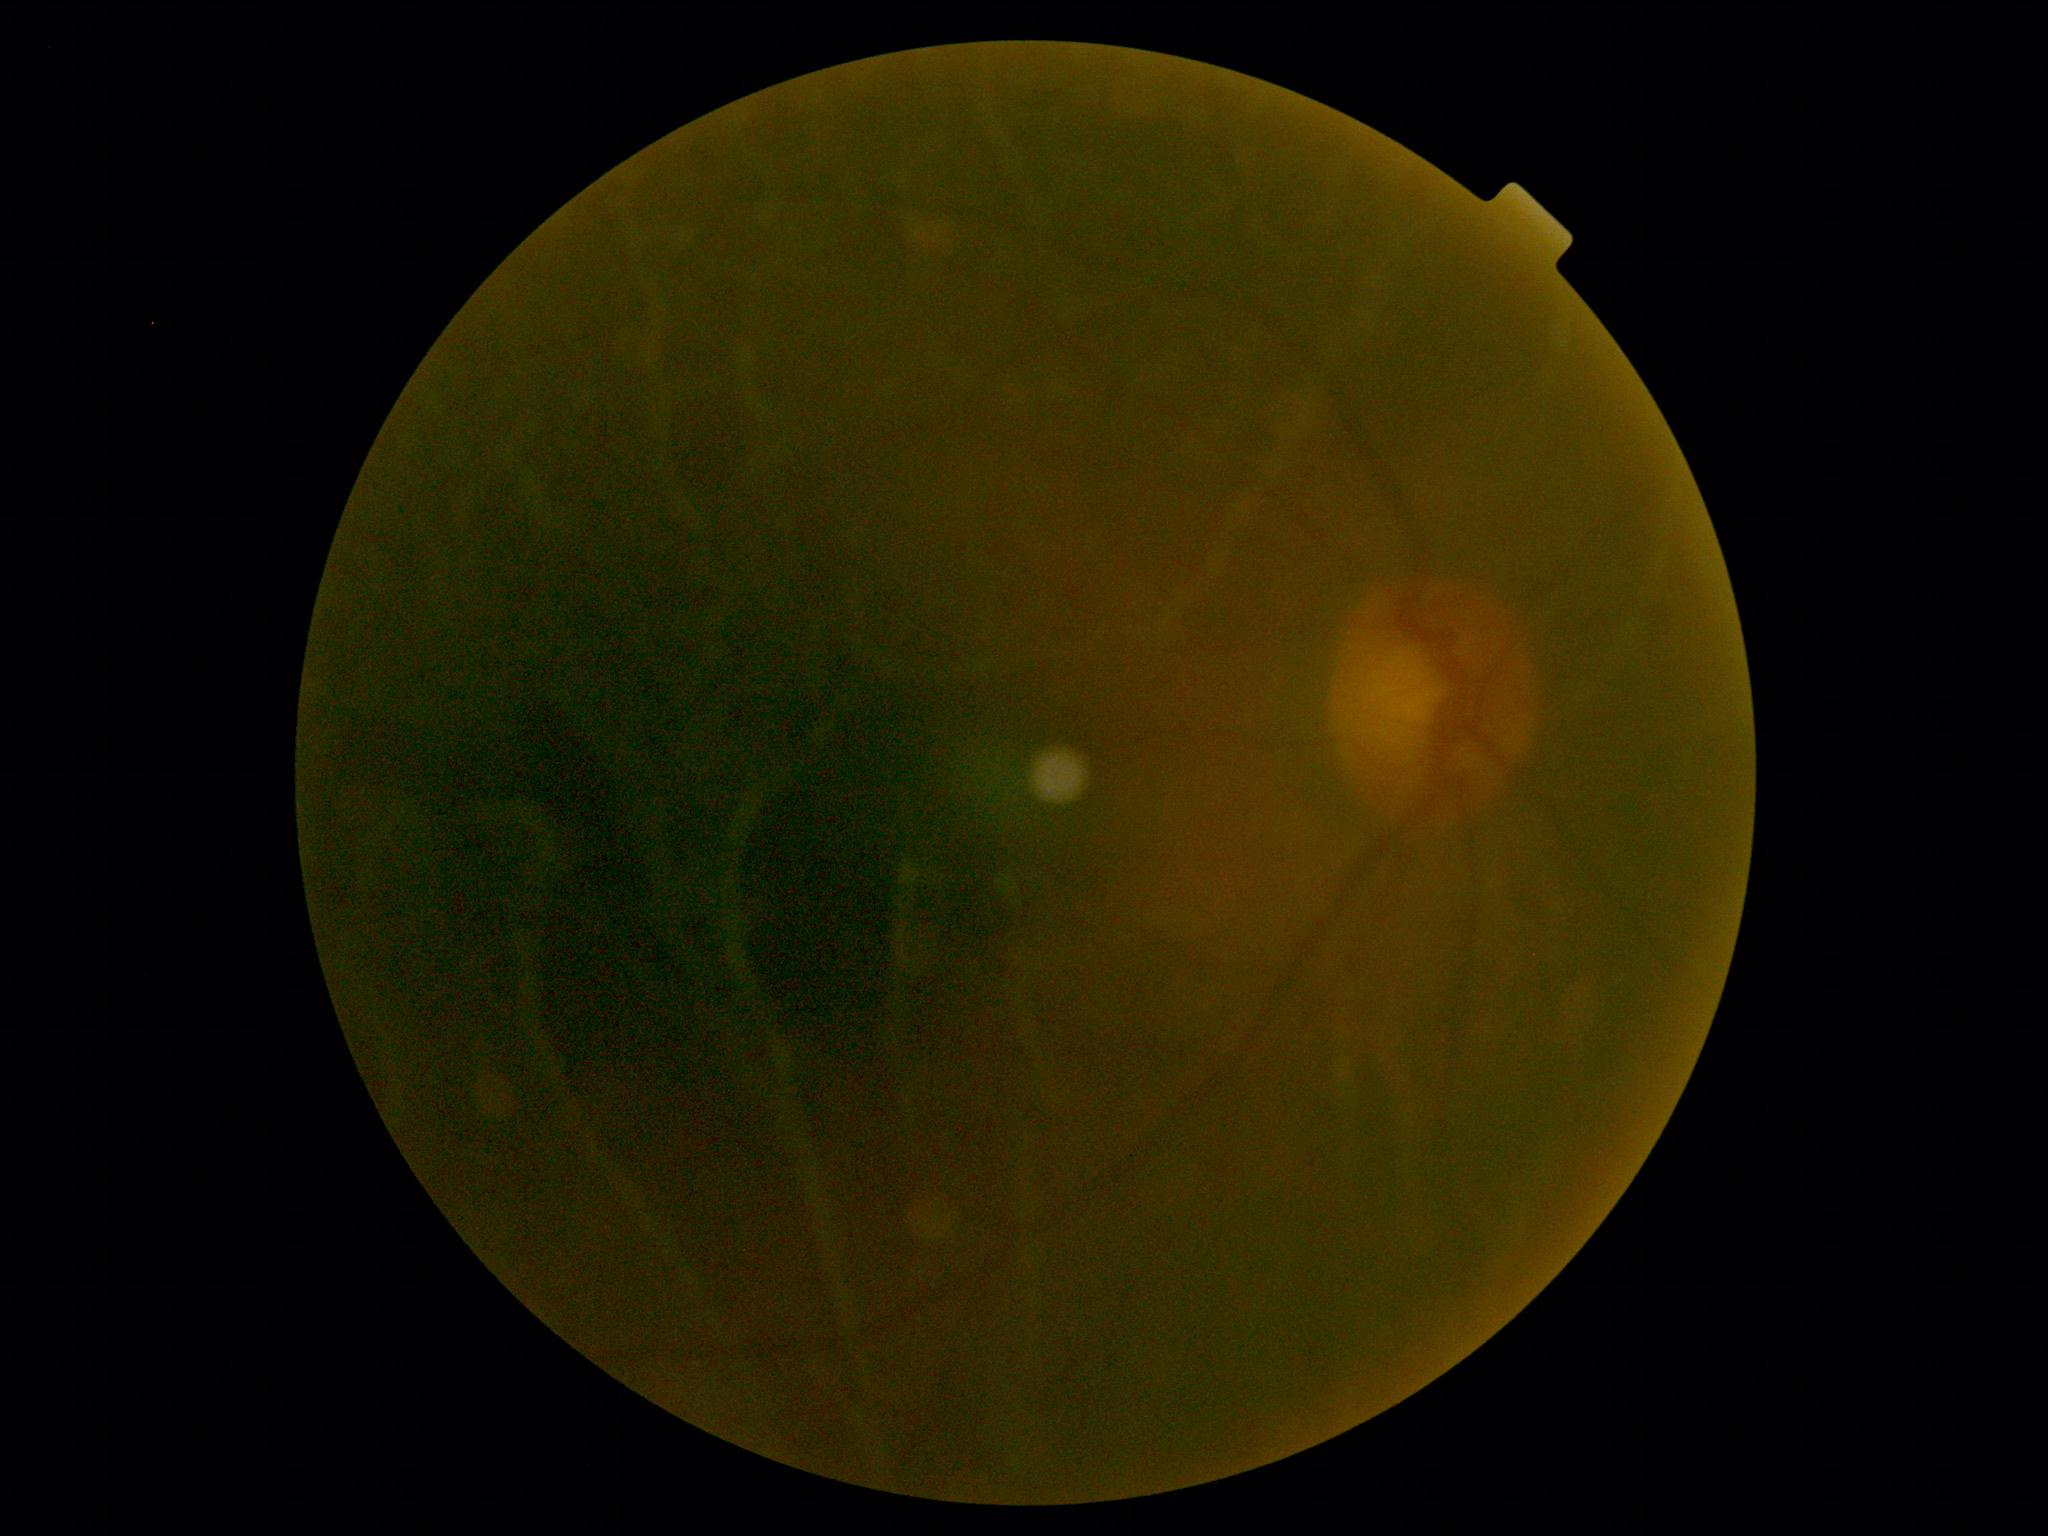
Ungradable image — DR severity cannot be determined.
DR stage is ungradable.